Acquired with a NIDEK AFC-230; FOV: 45 degrees; no pharmacologic dilation; color fundus photograph:
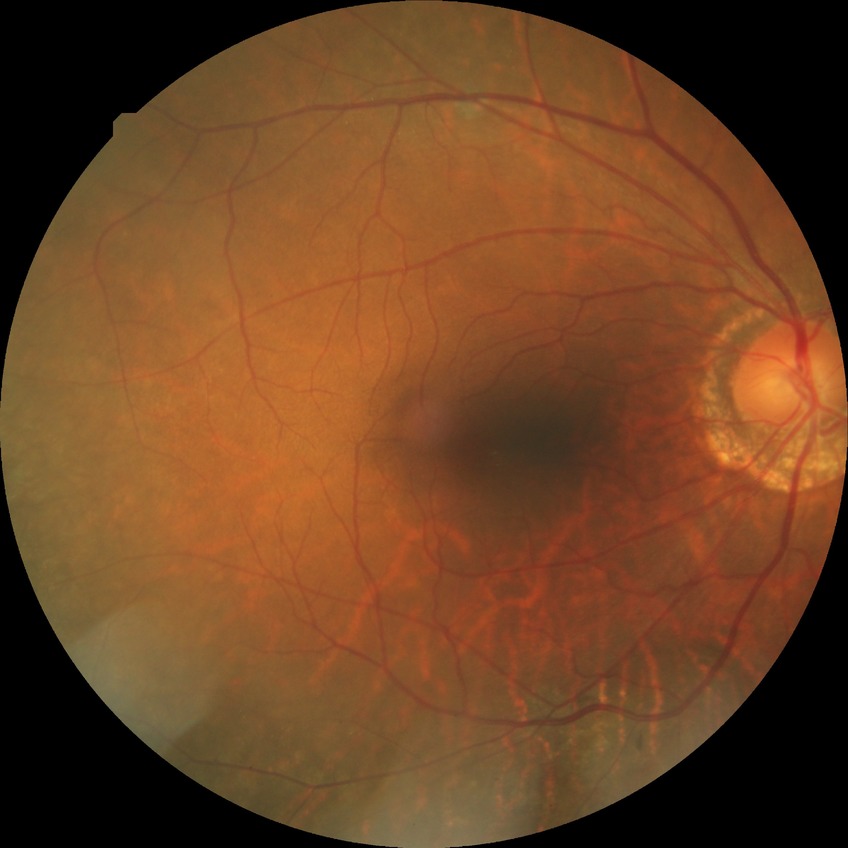

• diabetic retinopathy (DR) — no diabetic retinopathy (NDR)